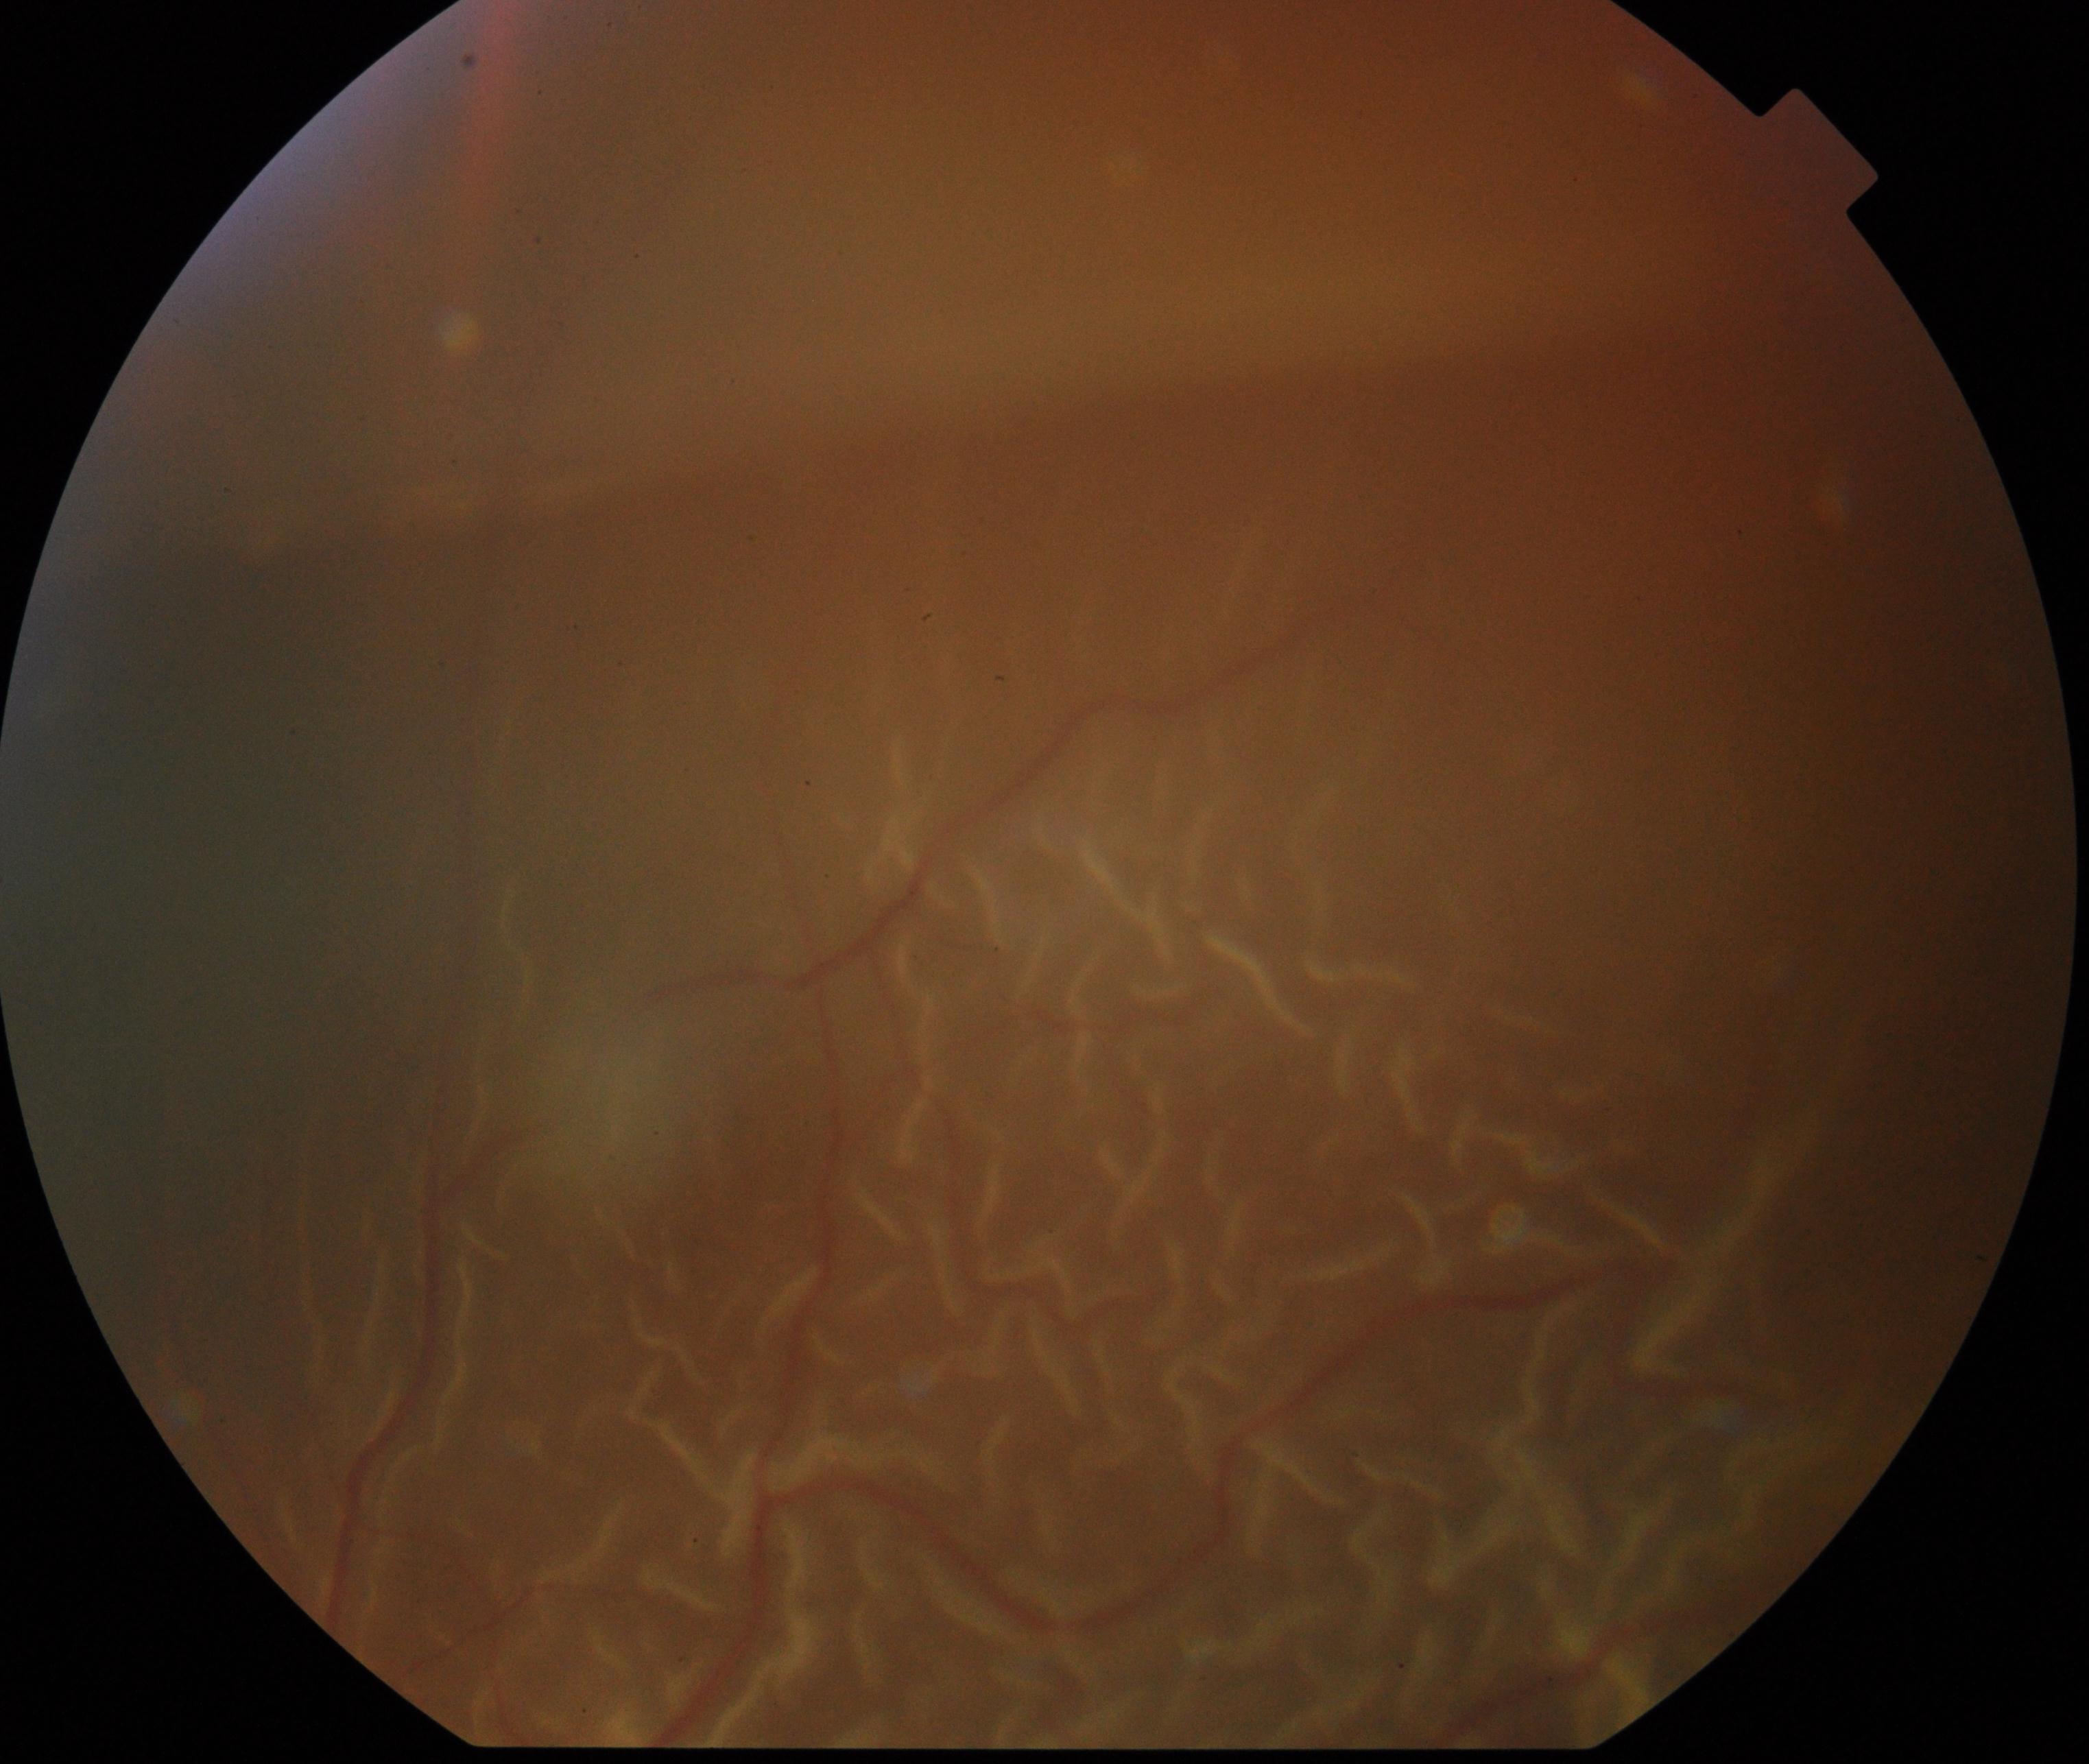

Retinal fundus photograph demonstrating rhegmatogenous retinal detachment.